Image size 2352x1568 · FOV: 45 degrees · CFP.
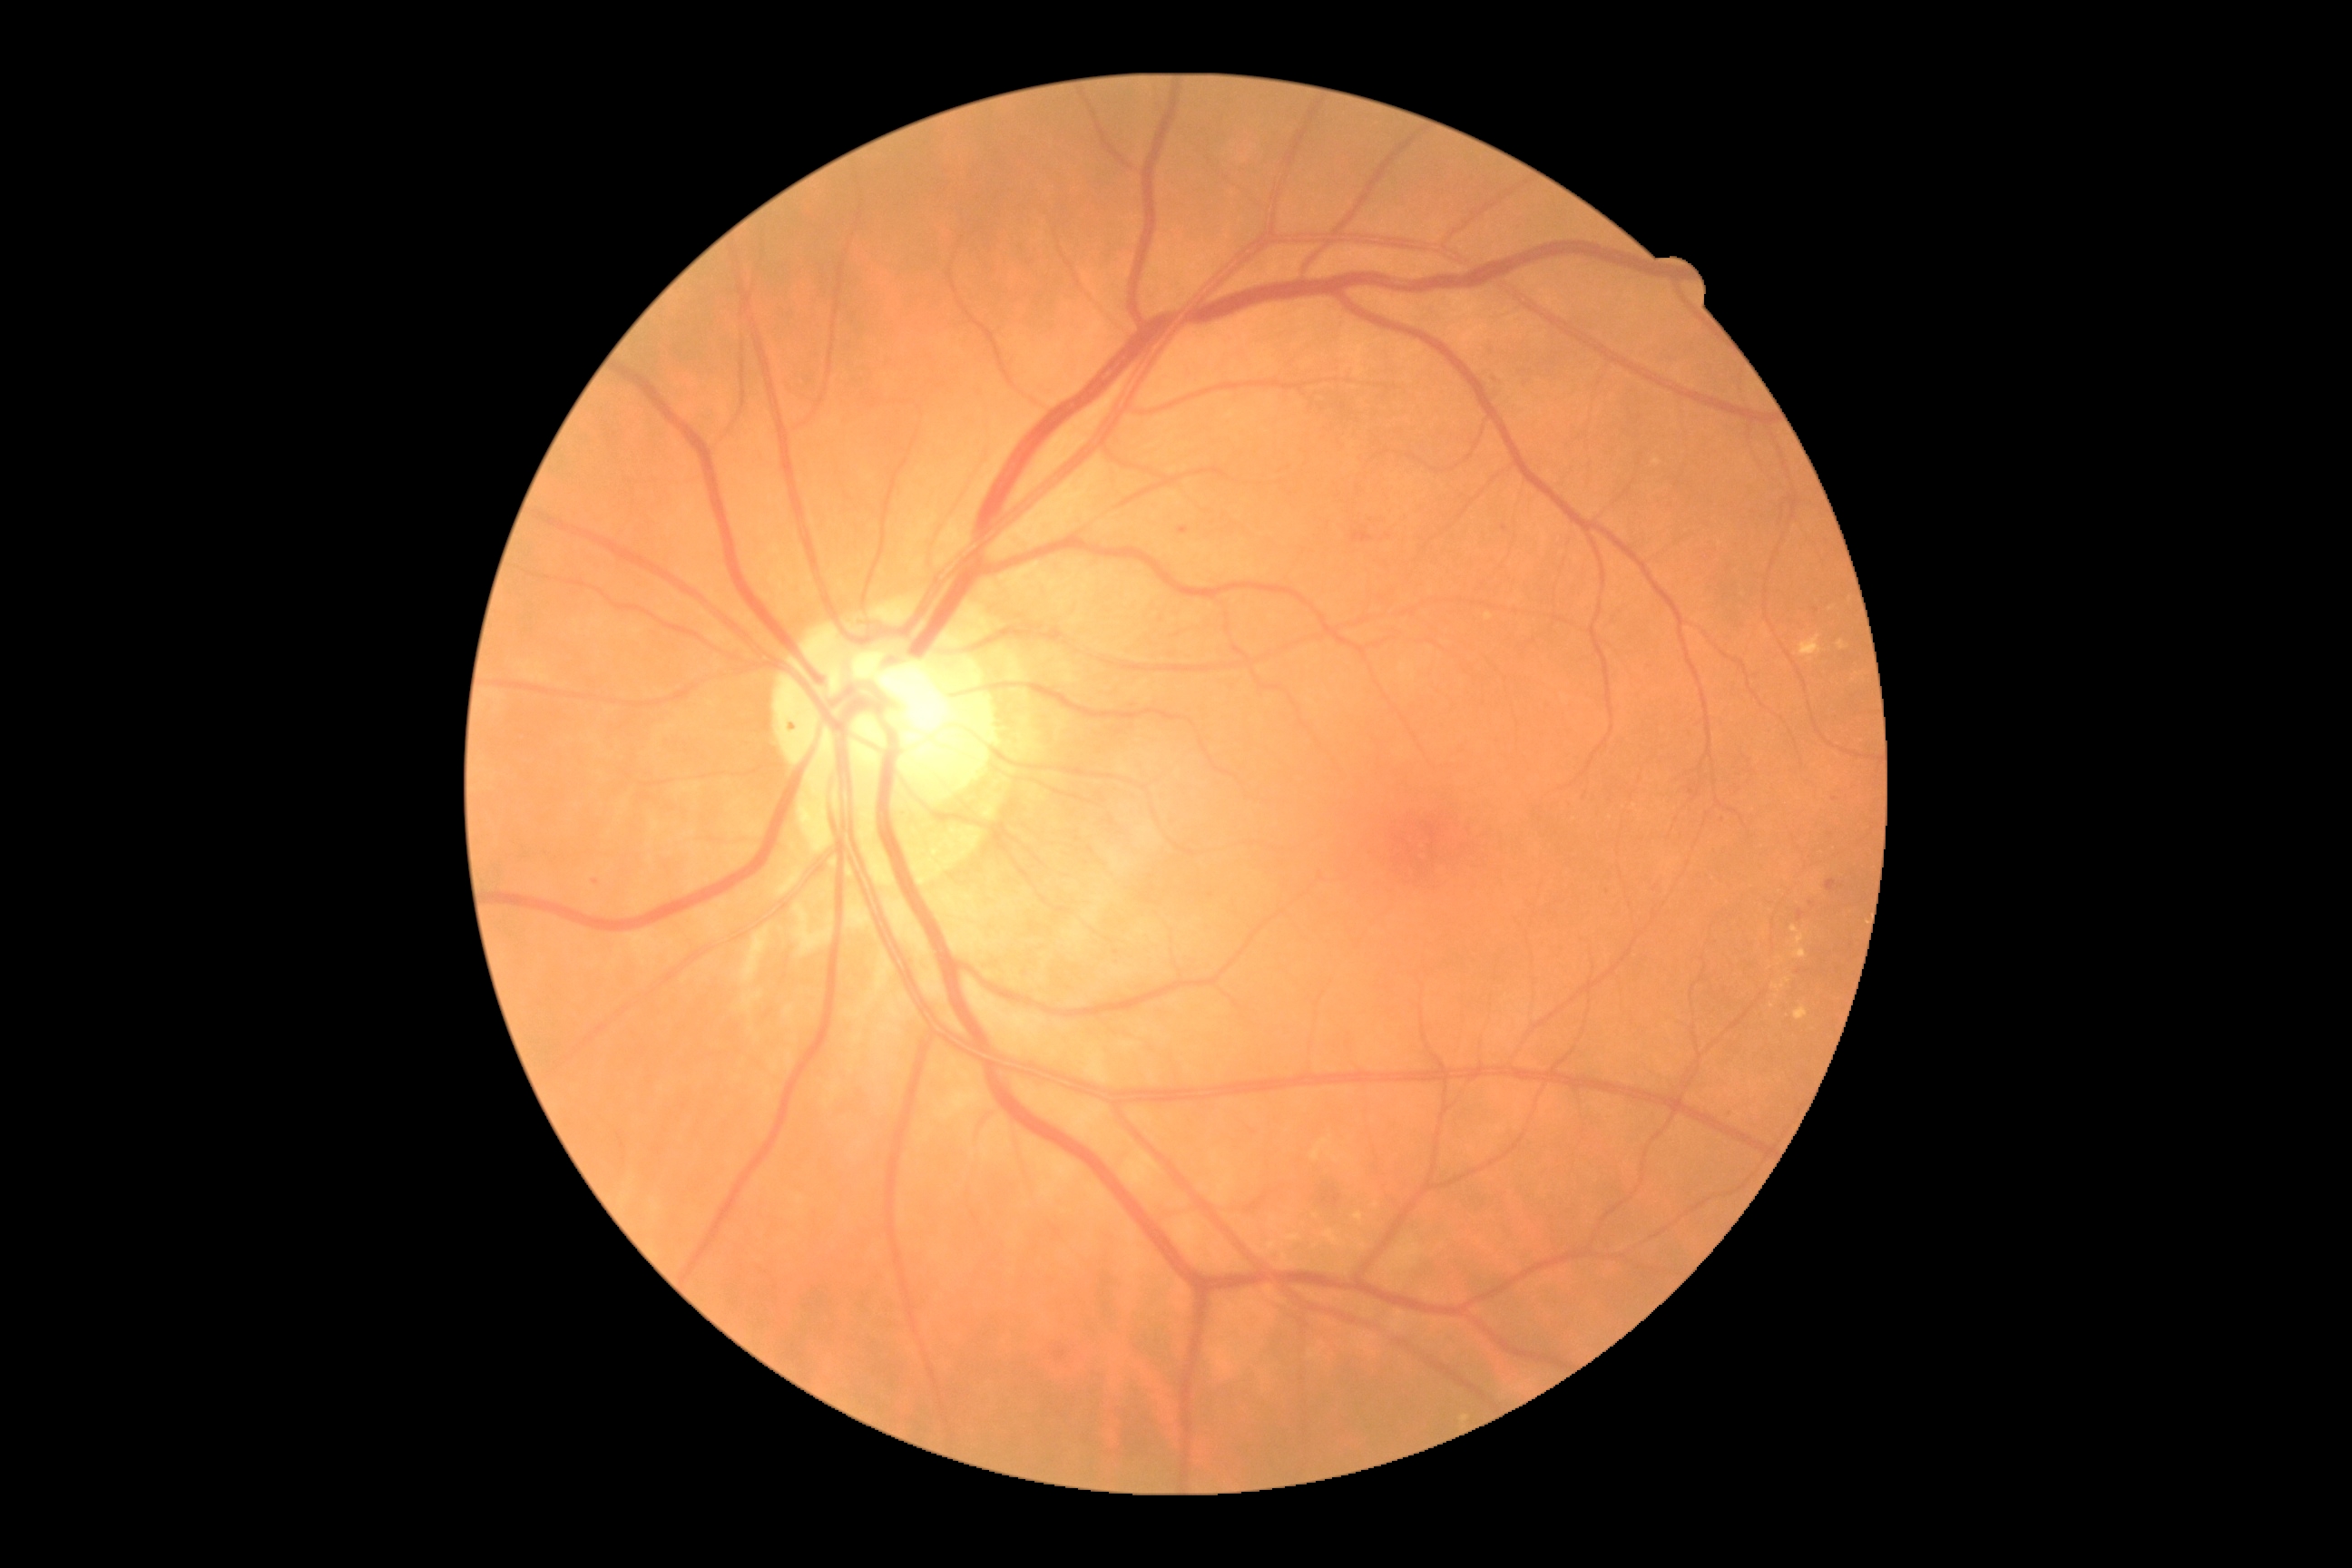

DR stage is moderate NPDR (grade 2)
Lesions identified (partial list):
* HEs: box(1333, 1195, 1342, 1208), box(1322, 1191, 1329, 1202), box(1353, 531, 1373, 544)
* Small HEs near [x=1335, y=1191]
* EXs (subset): box(1839, 640, 1847, 651), box(1324, 1230, 1346, 1248), box(1282, 1253, 1295, 1268), box(1794, 948, 1807, 959), box(1284, 1235, 1302, 1242), box(1772, 983, 1785, 992), box(1799, 634, 1821, 658), box(1485, 614, 1493, 622)
* Small EXs near [x=1315, y=1246], [x=1337, y=1160], [x=1772, y=1007], [x=1273, y=1221]
* MAs (subset): box(1179, 527, 1190, 534), box(1827, 879, 1838, 892), box(789, 721, 798, 732), box(1730, 1110, 1740, 1121), box(1798, 910, 1805, 921)
* Small MAs near [x=1211, y=895], [x=1111, y=822], [x=1812, y=904], [x=1505, y=528], [x=1696, y=798], [x=1117, y=954], [x=1836, y=799], [x=1691, y=791], [x=595, y=882]
* SEs: none identified